1240 x 1240 pixels; 100° field of view (Phoenix ICON); Phoenix ICON wide-field infant fundus image.
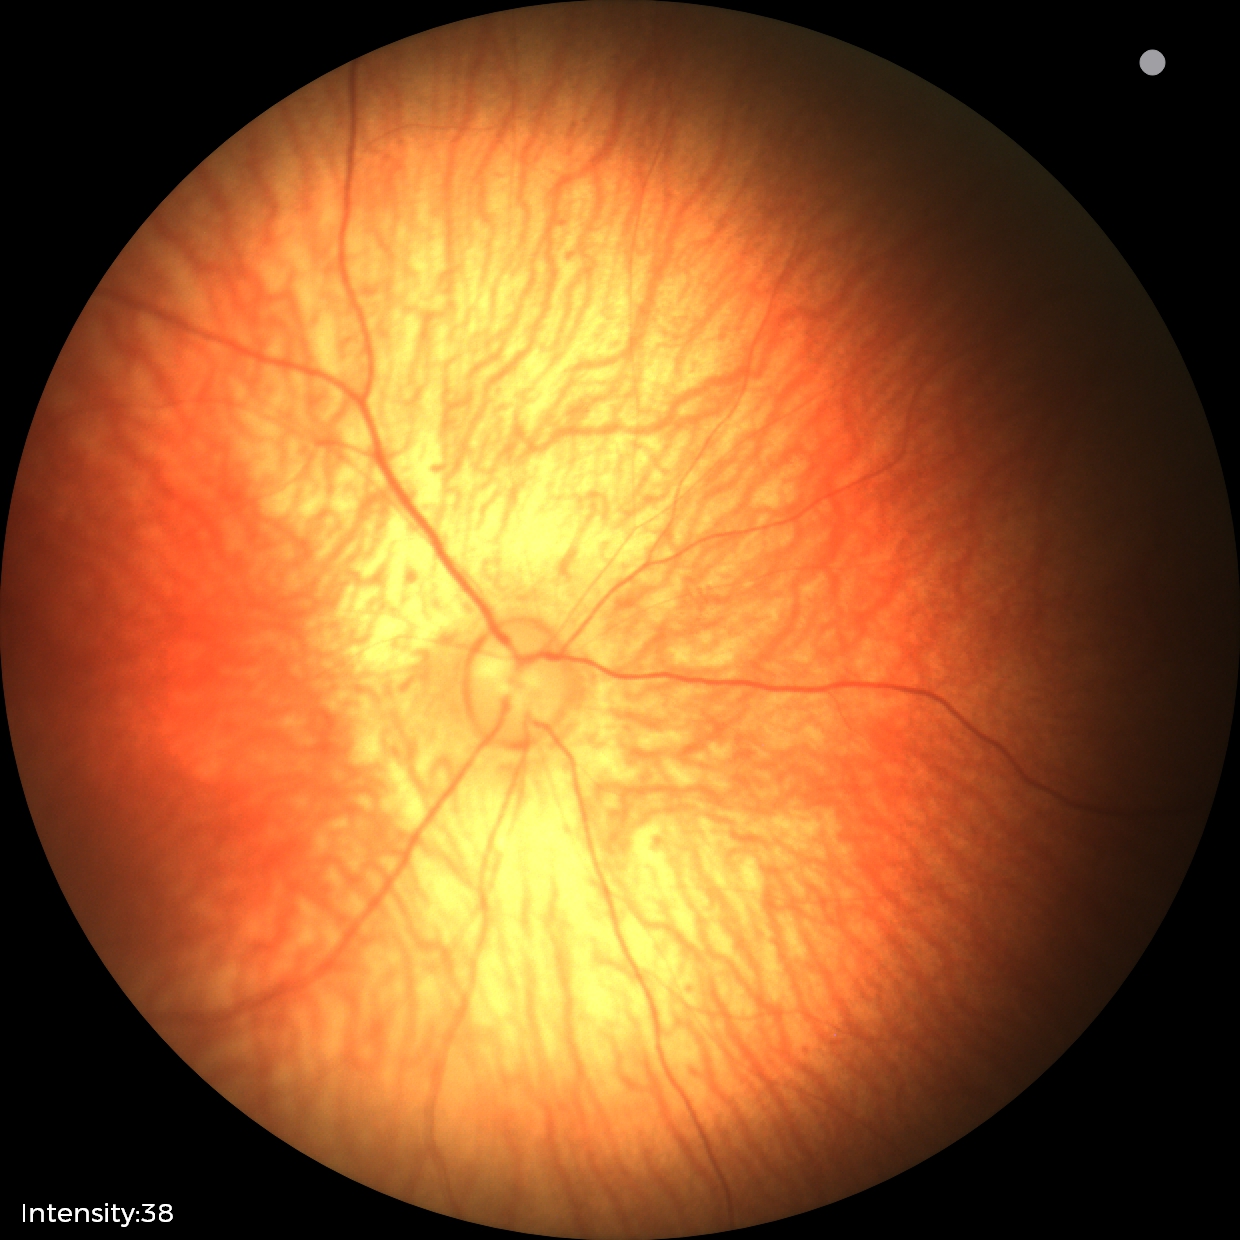
Screening examination with no abnormal retinal findings.